Modified Davis classification
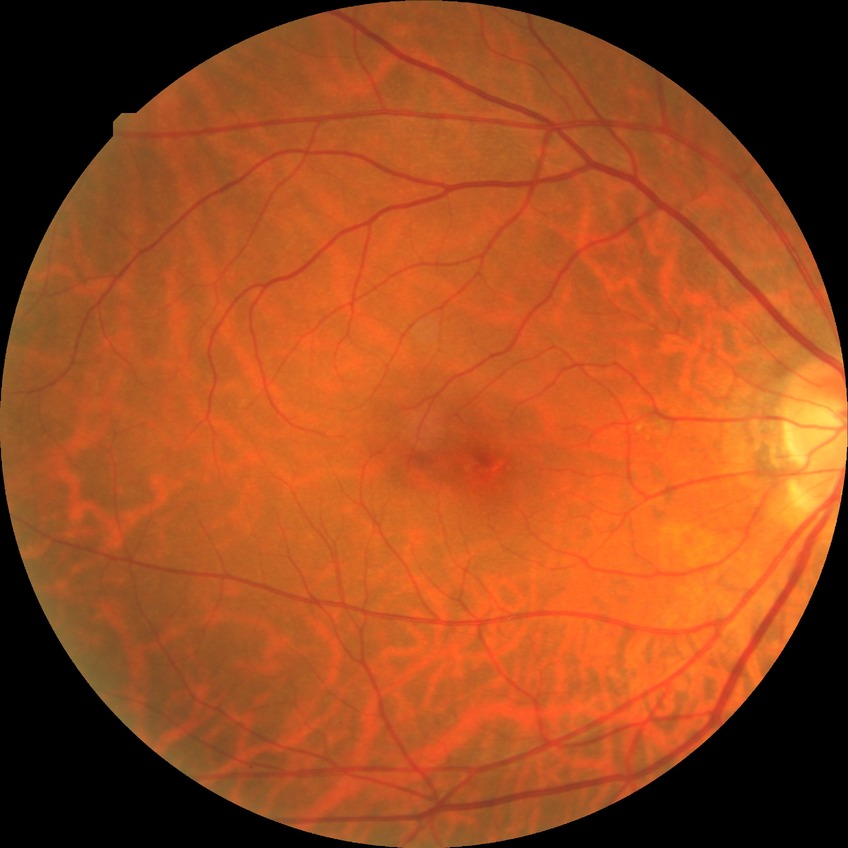 Annotations:
– diabetic retinopathy (DR): no diabetic retinopathy (NDR)